45° field of view. Color fundus image.
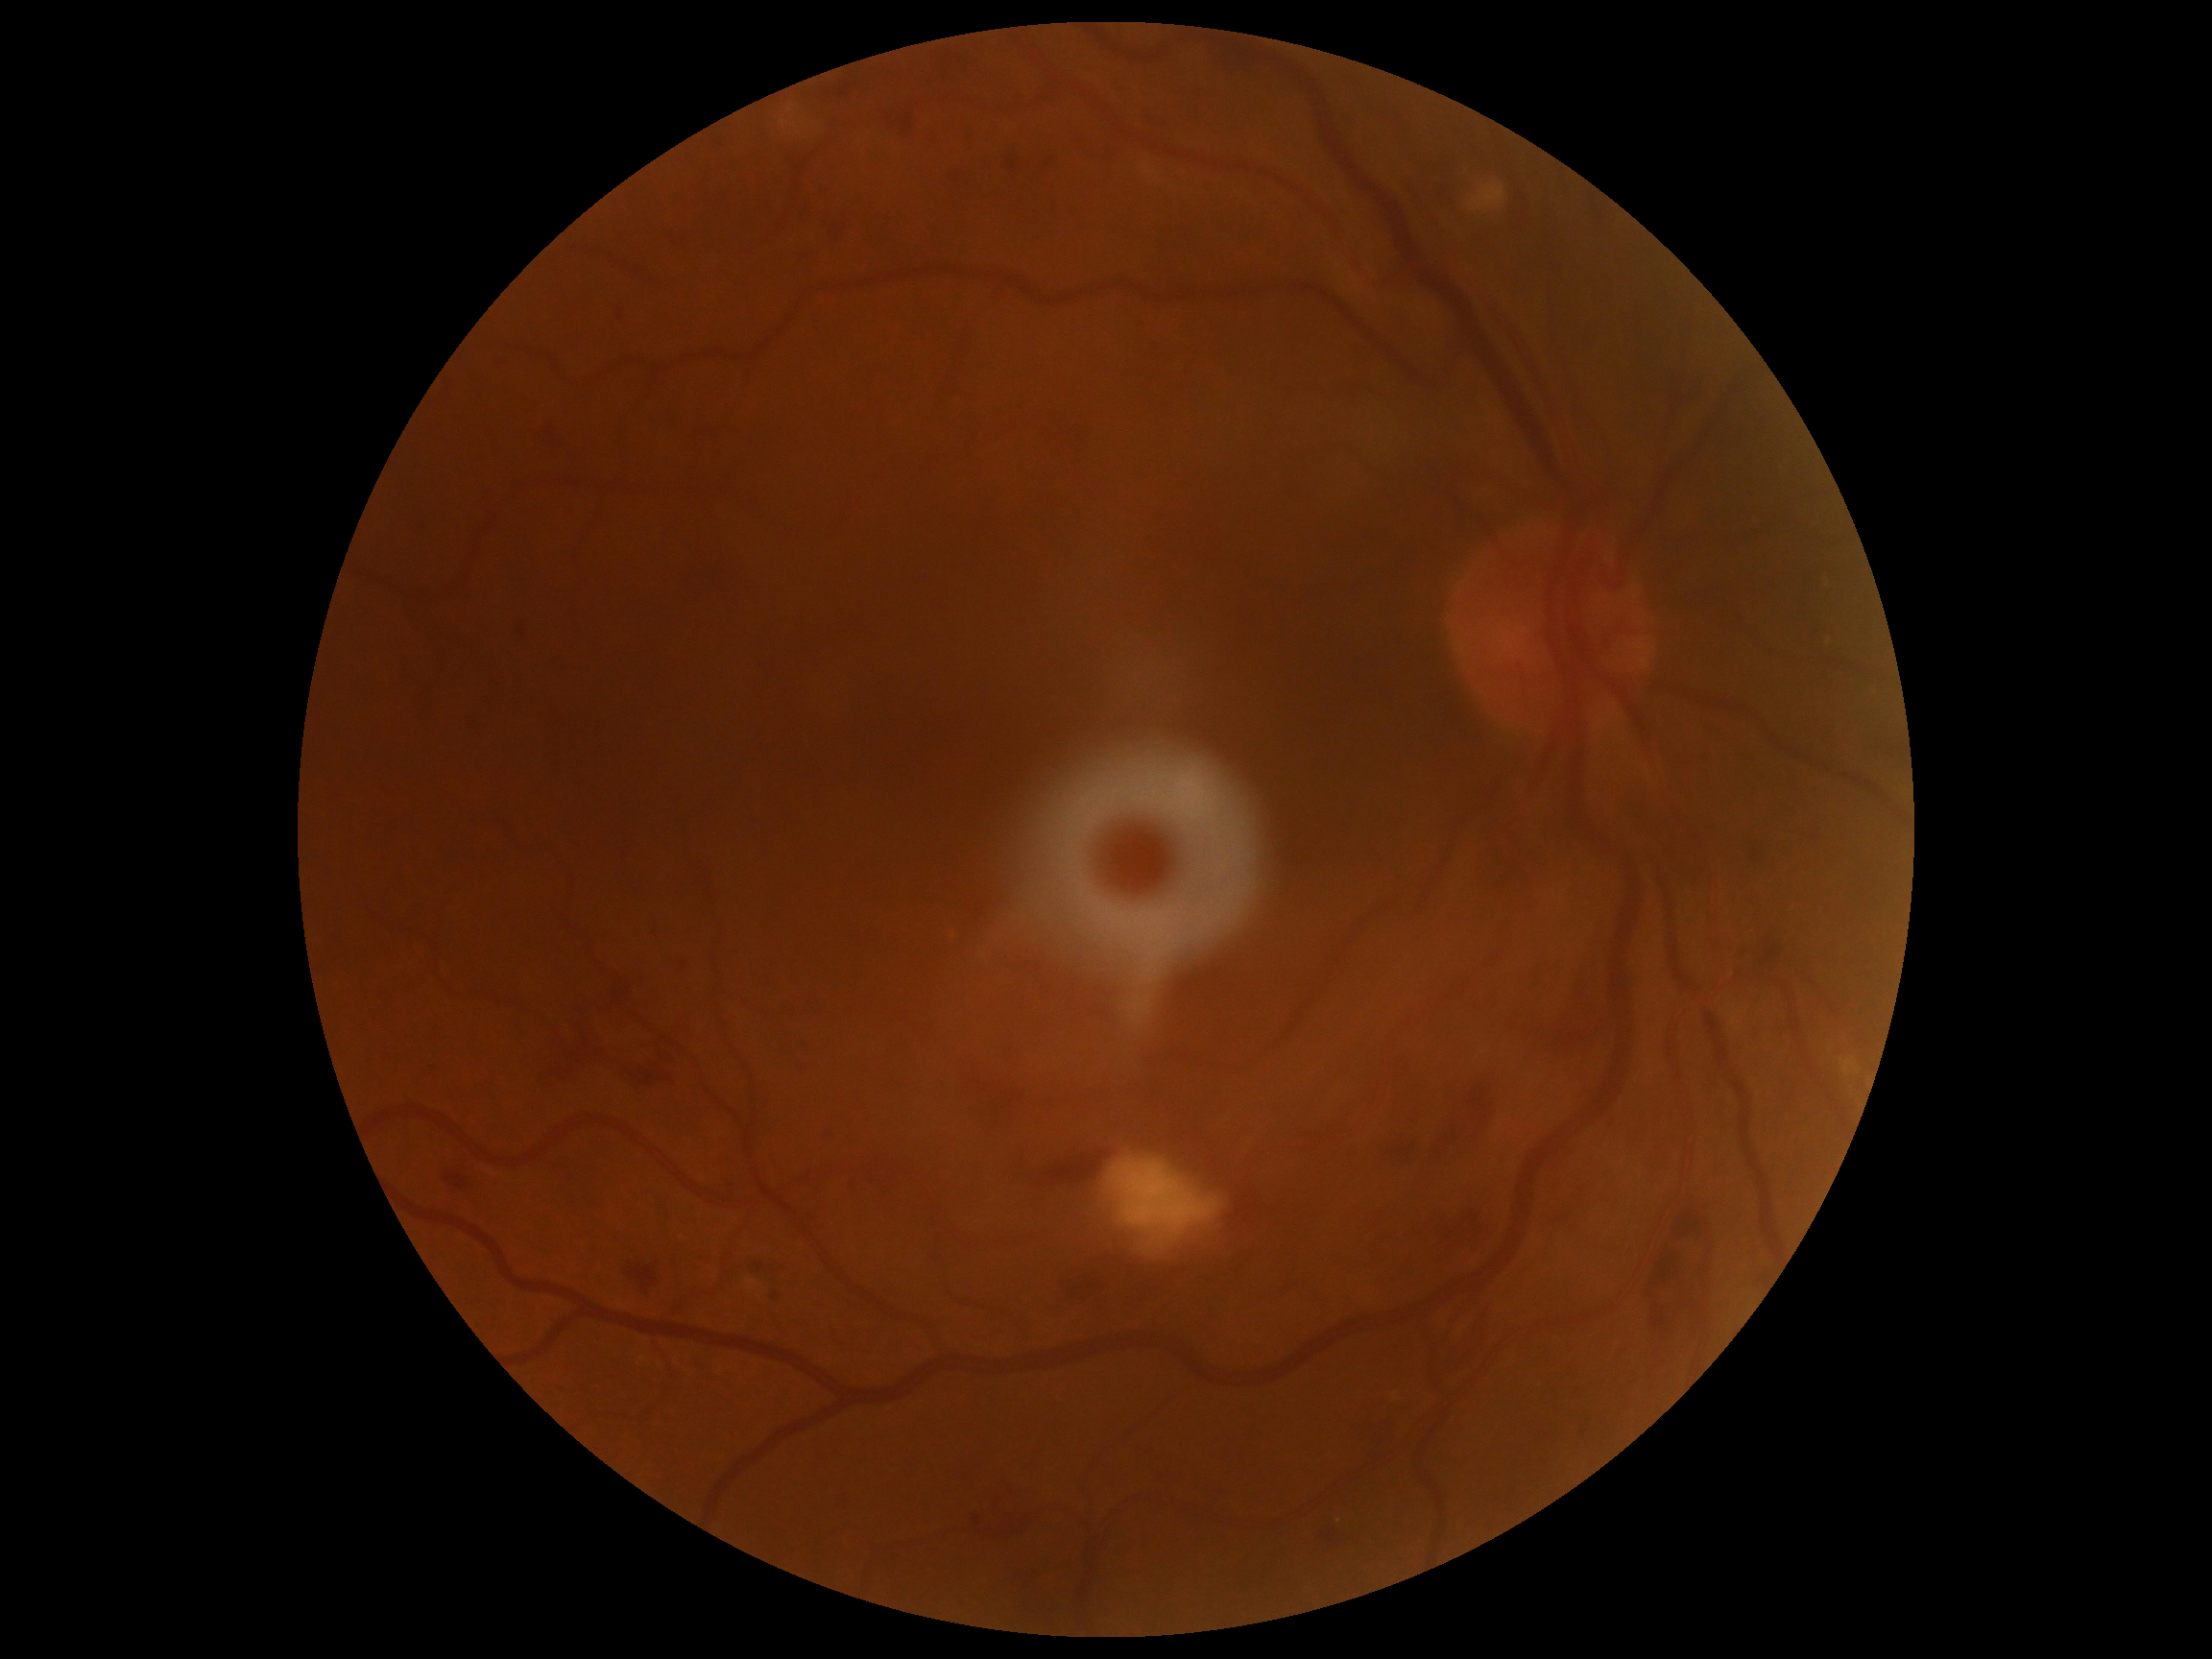
DR severity: 2.